Diabetic retinopathy graded by the modified Davis classification. 45° field of view.
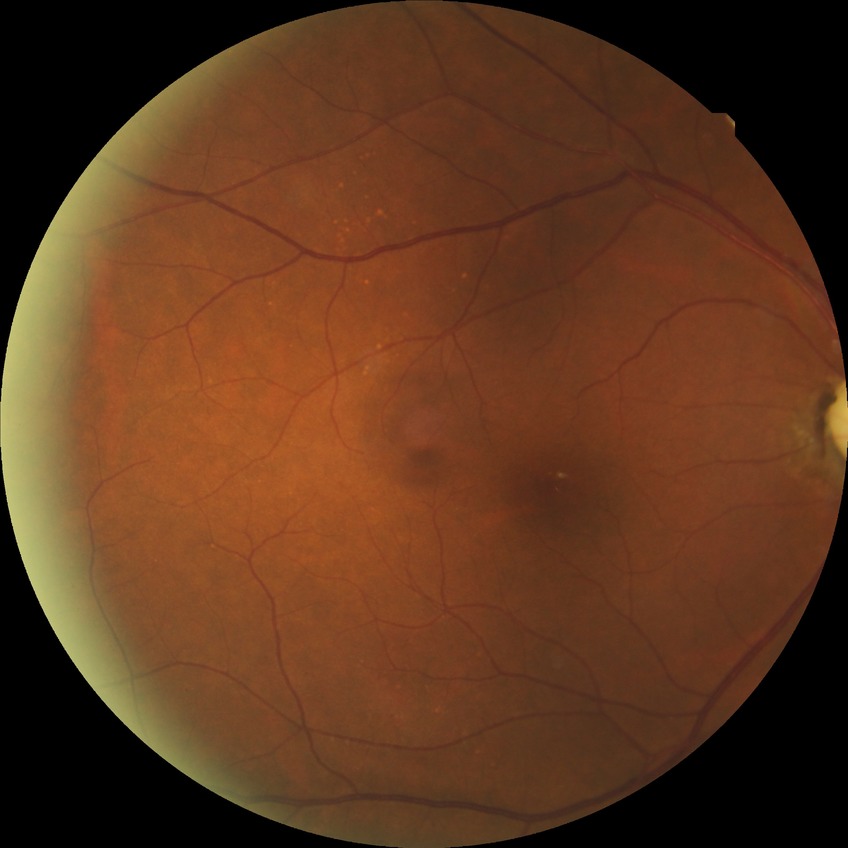
diabetic retinopathy grade = no diabetic retinopathy